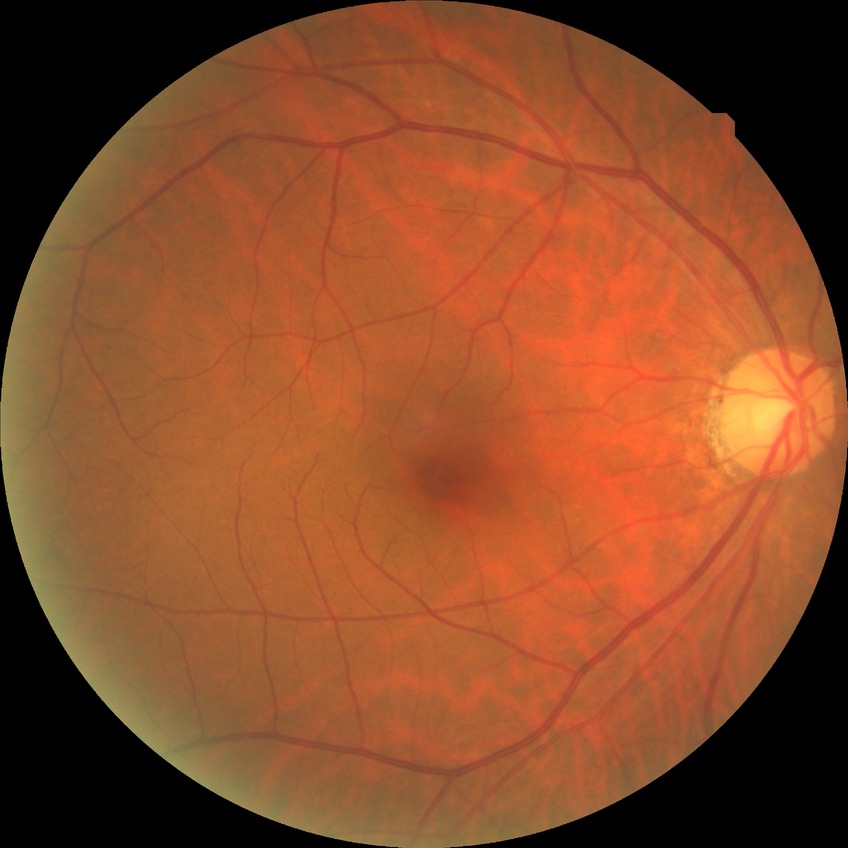

Retinopathy grade: no diabetic retinopathy.